45-degree field of view. 2352 x 1568 pixels. Fundus photo
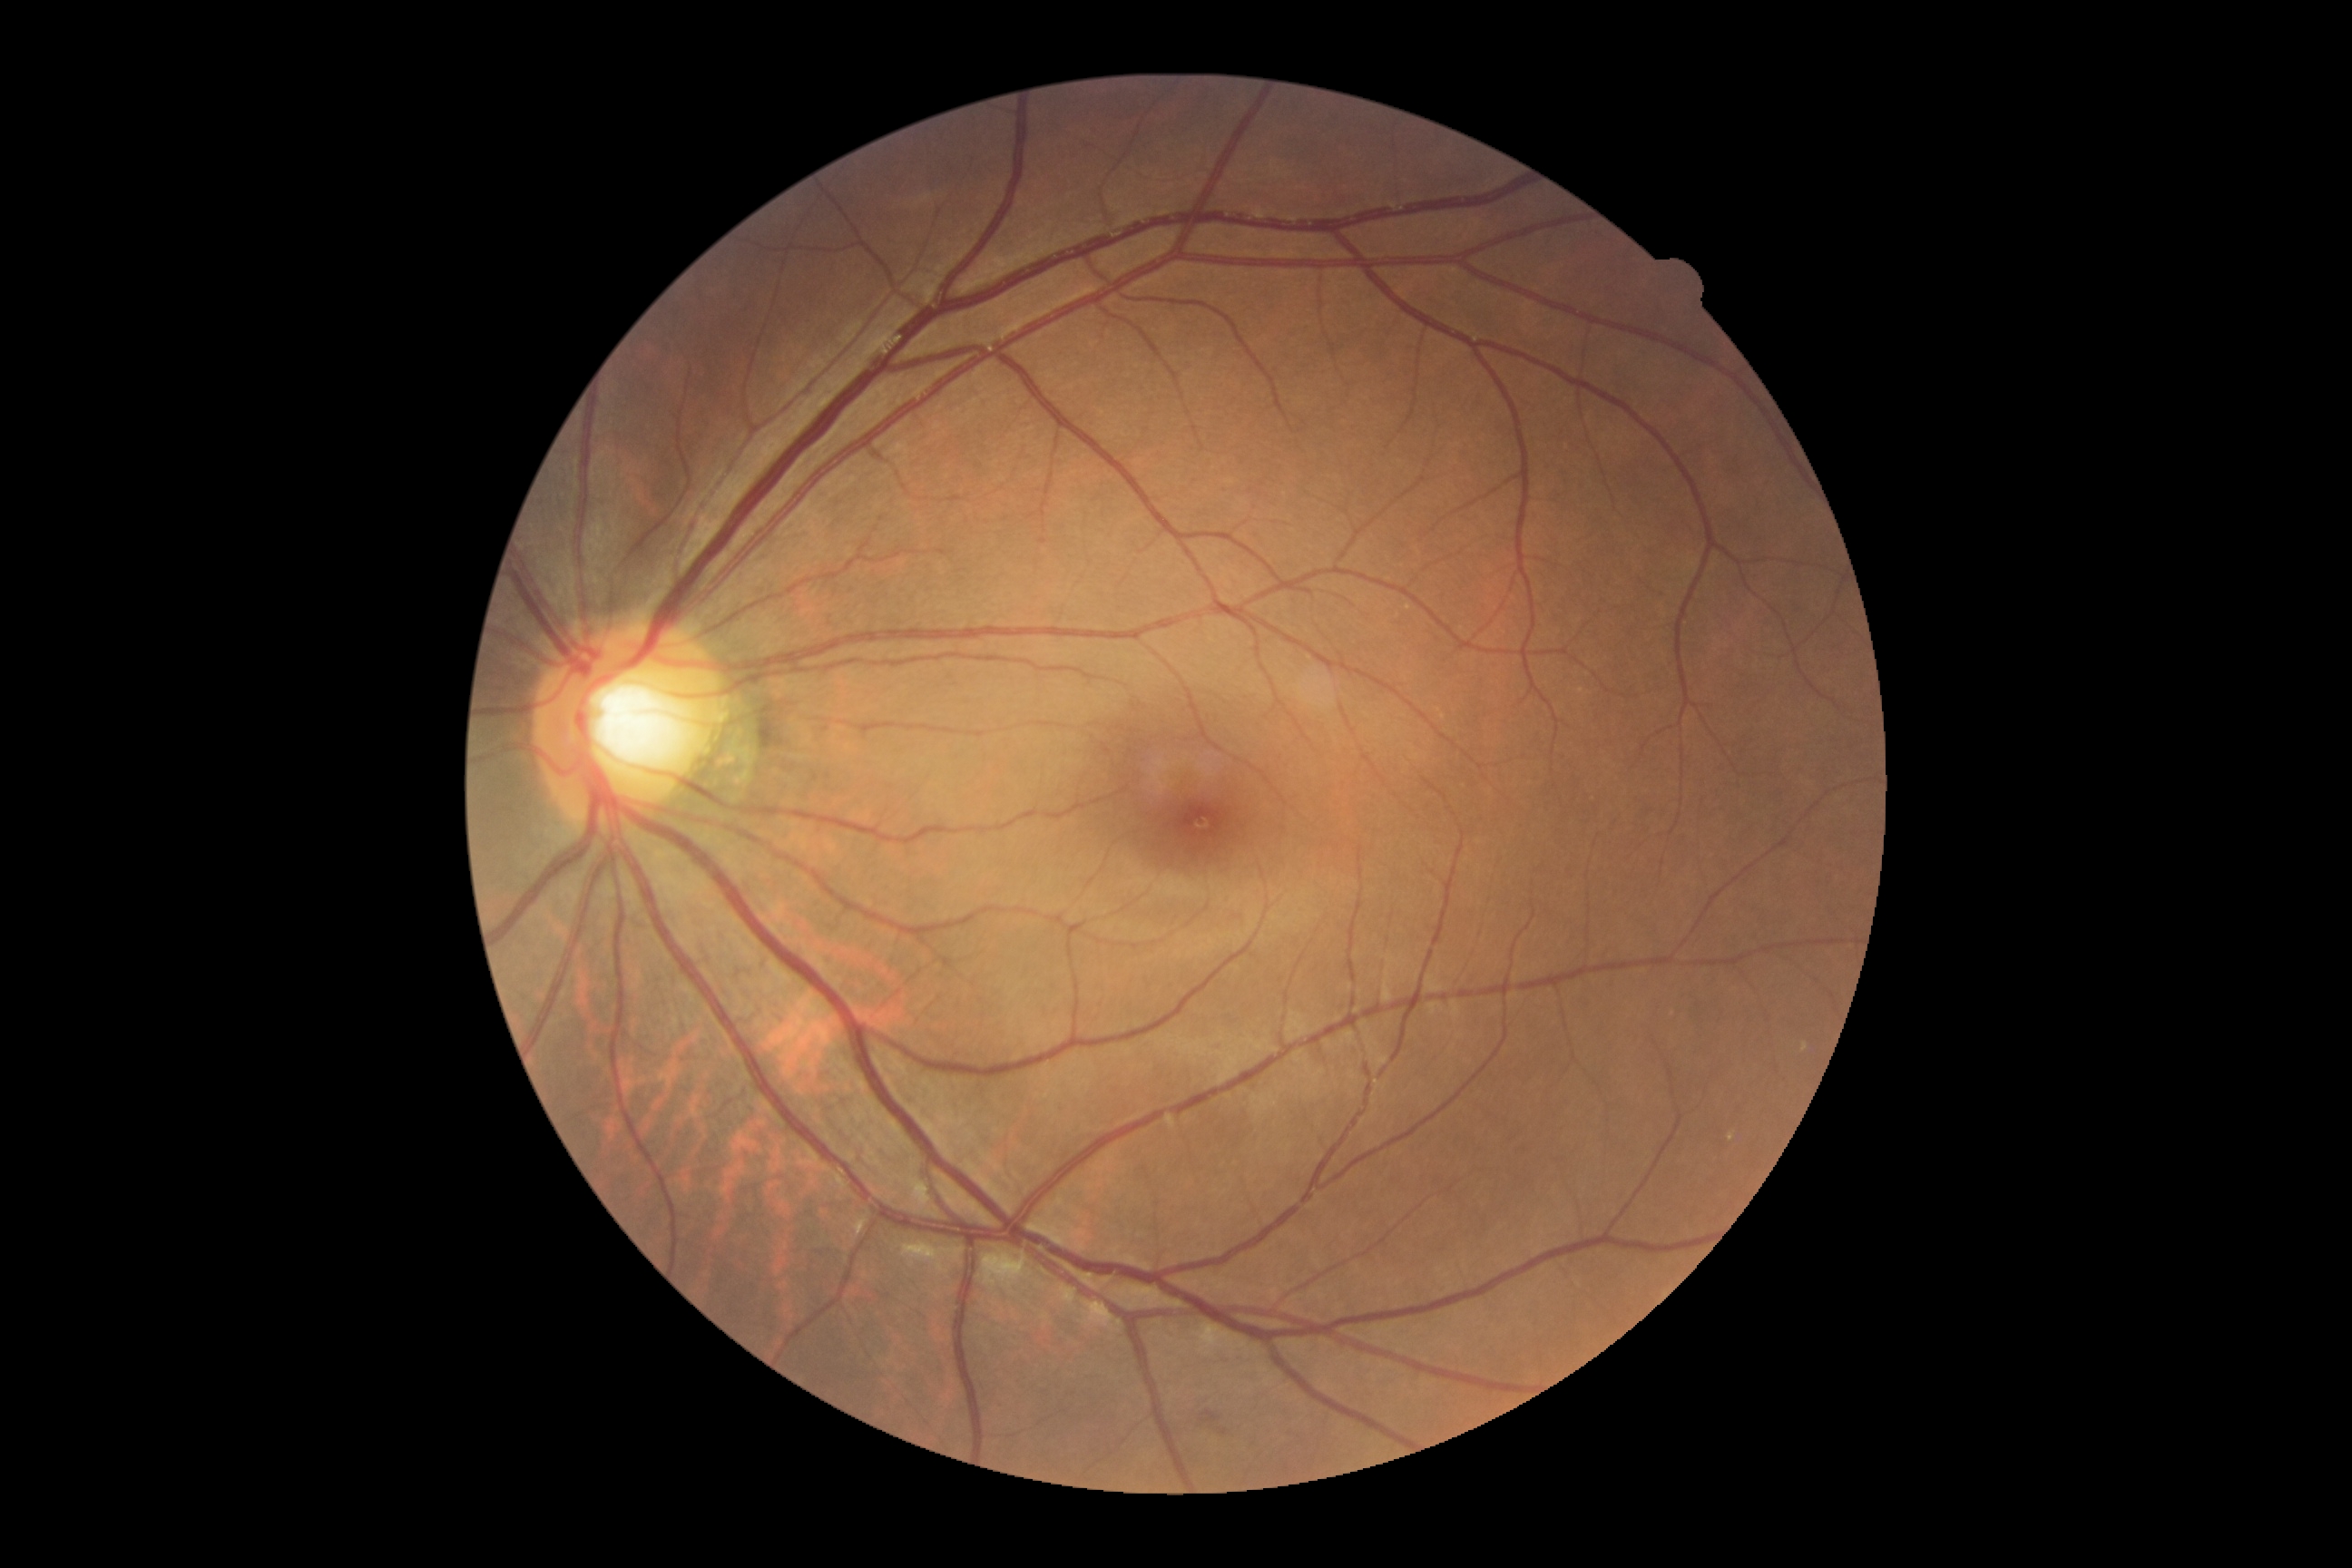 diabetic retinopathy (DR) = no apparent diabetic retinopathy (grade 0)